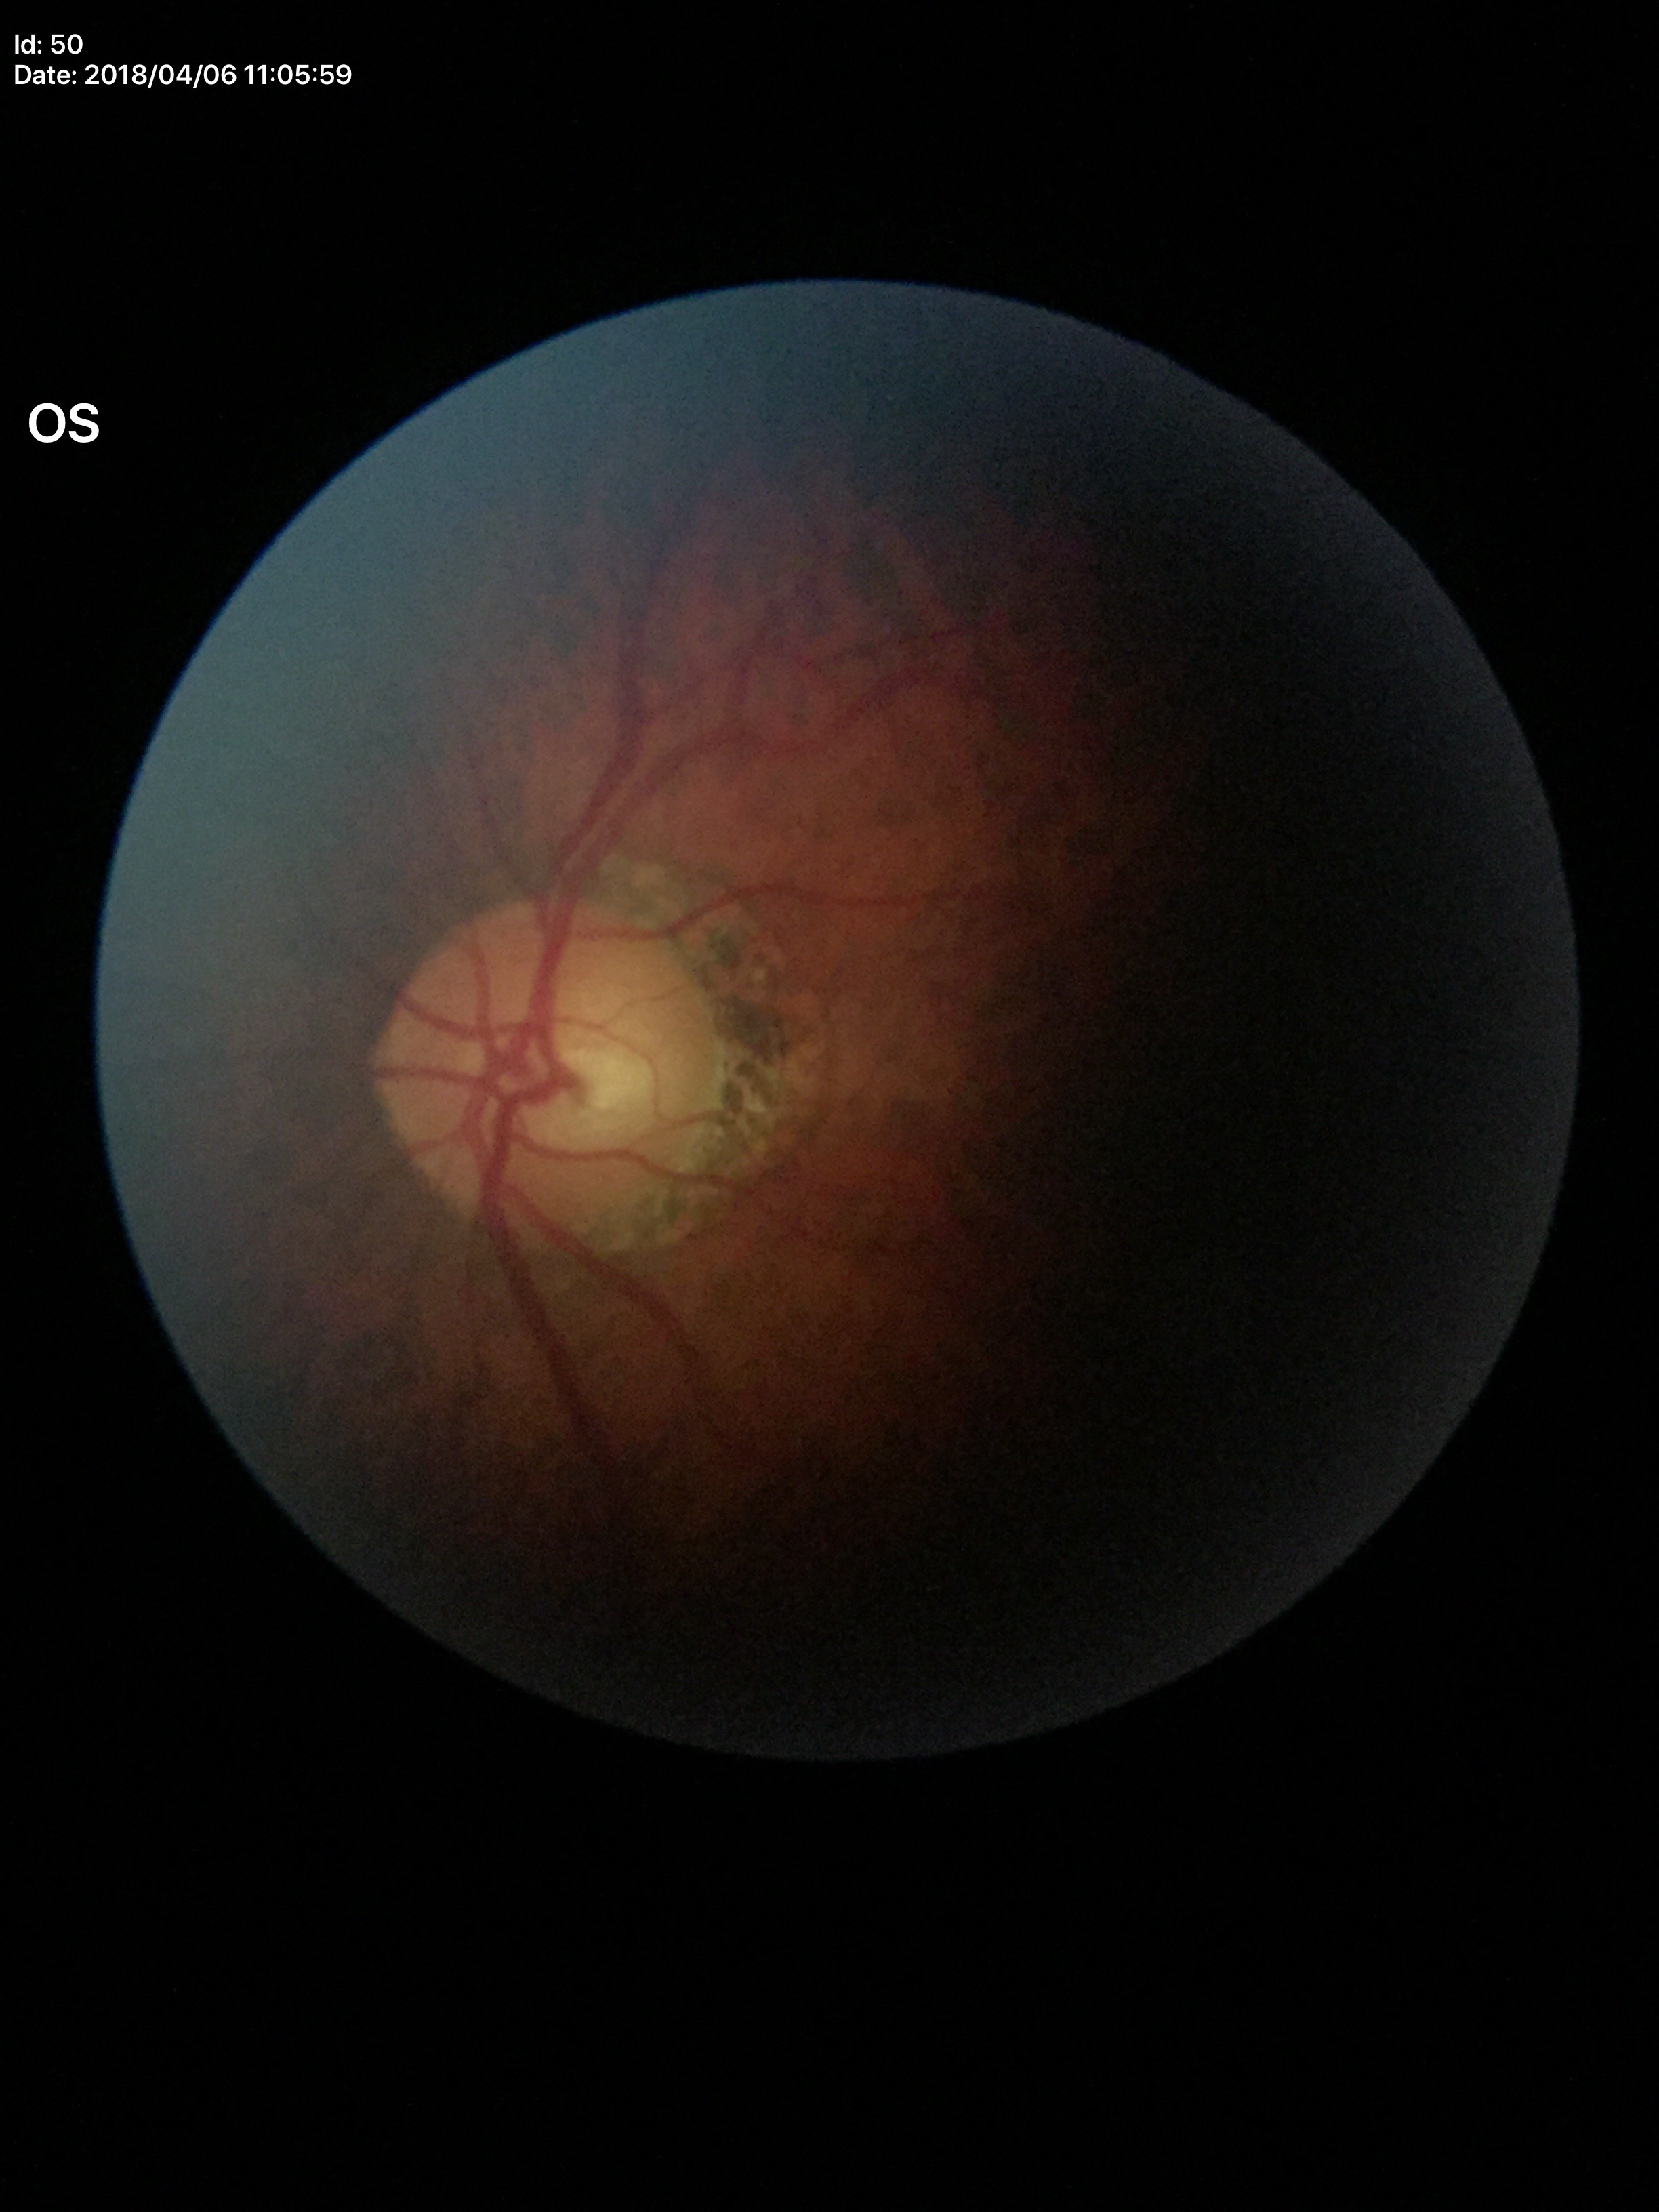 Optic disc analysis:
* Glaucoma screening impression: not suspect (5/5 ophthalmologists in agreement)
* vertical CDR (VCDR): 0.48
* area C/D ratio (ACDR): 0.27